640x480 · pediatric retinal photograph (wide-field)
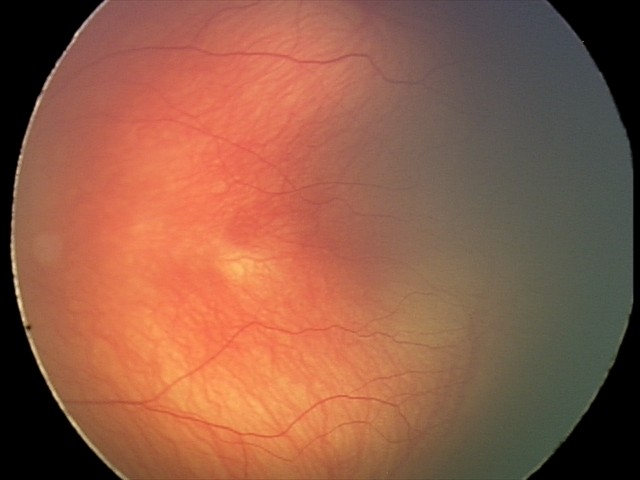 No plus disease. Screening series with retinopathy of prematurity (ROP) stage 2 — ridge with height and width at the demarcation line.